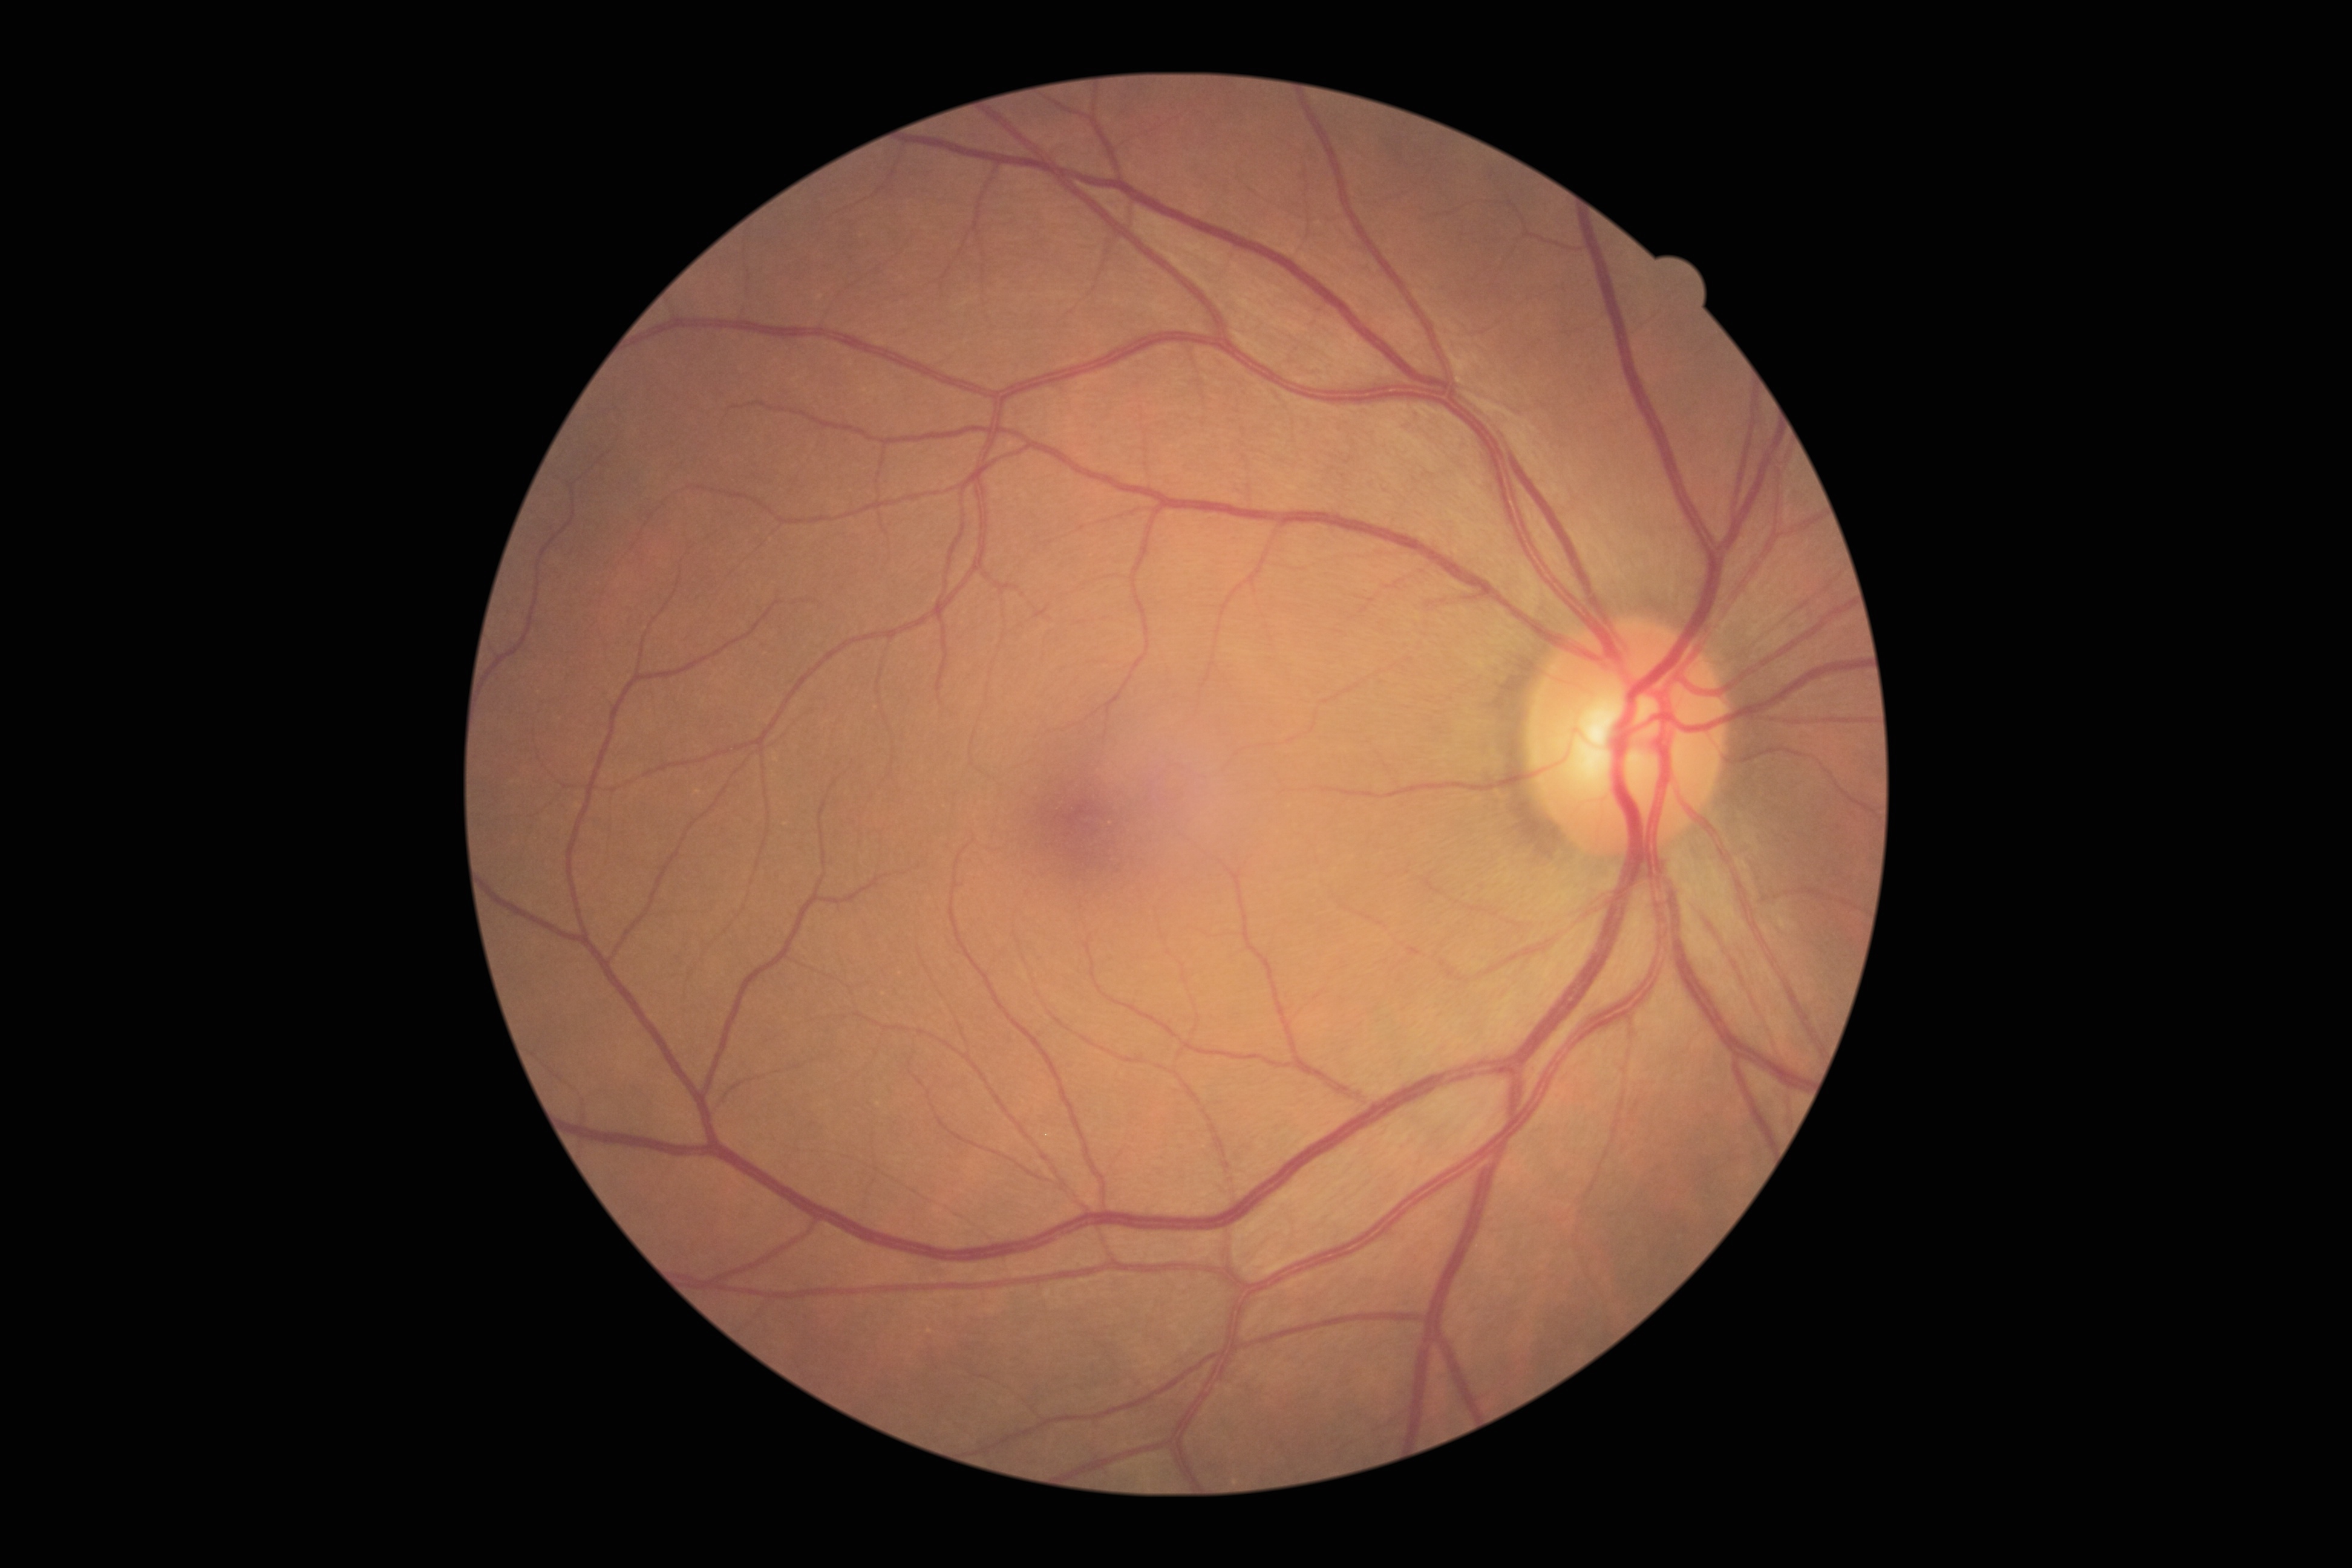
No signs of diabetic retinopathy. Diabetic retinopathy is no apparent retinopathy (grade 0).